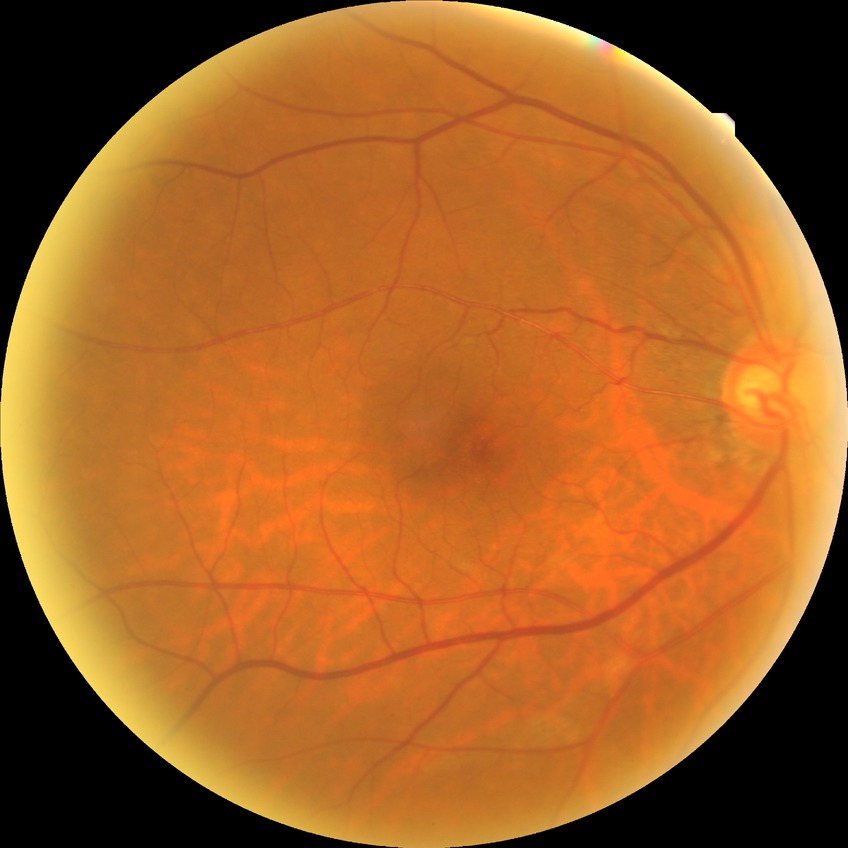

Diabetic retinopathy (DR) is NDR (no diabetic retinopathy).